Image size 640x480 · 130° field of view (Clarity RetCam 3) · pediatric wide-field fundus photograph — 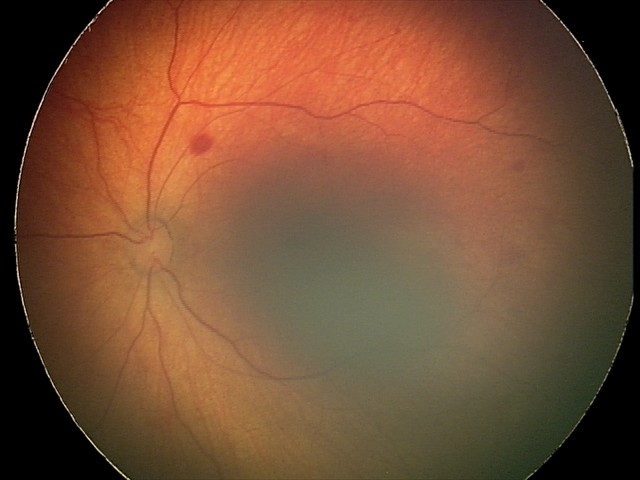

Series diagnosed as retinal hemorrhages.